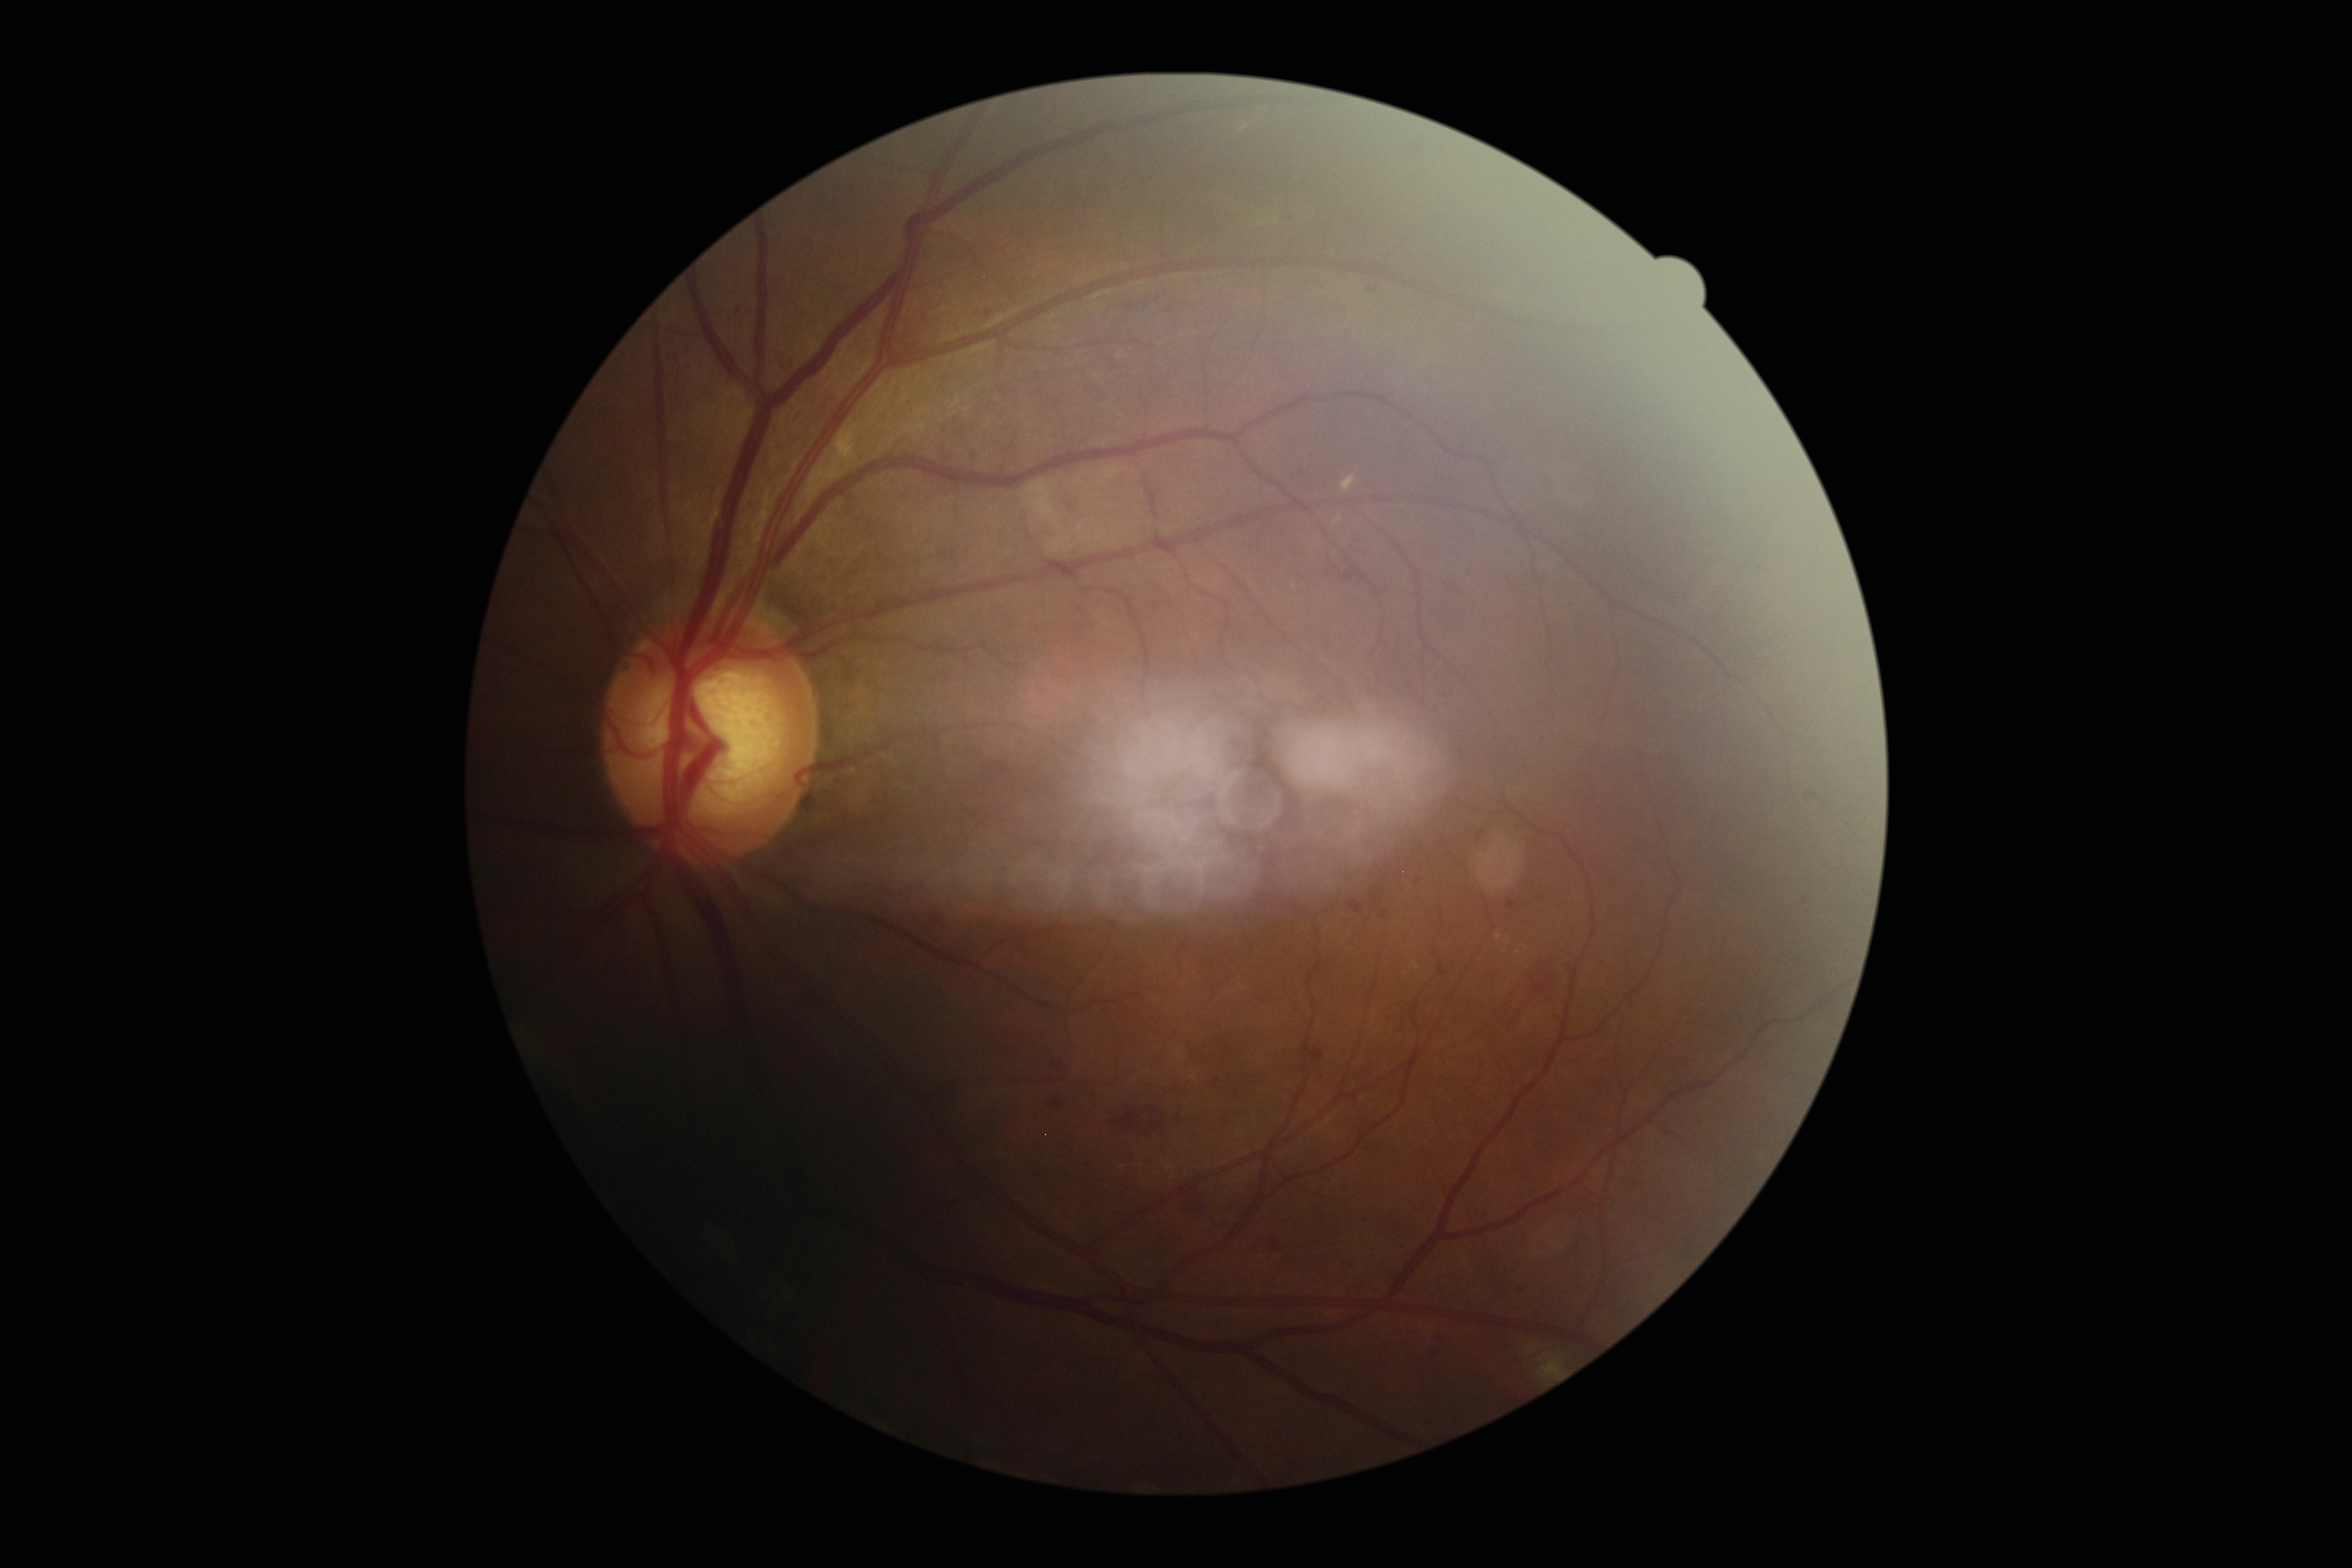 DR: 2.